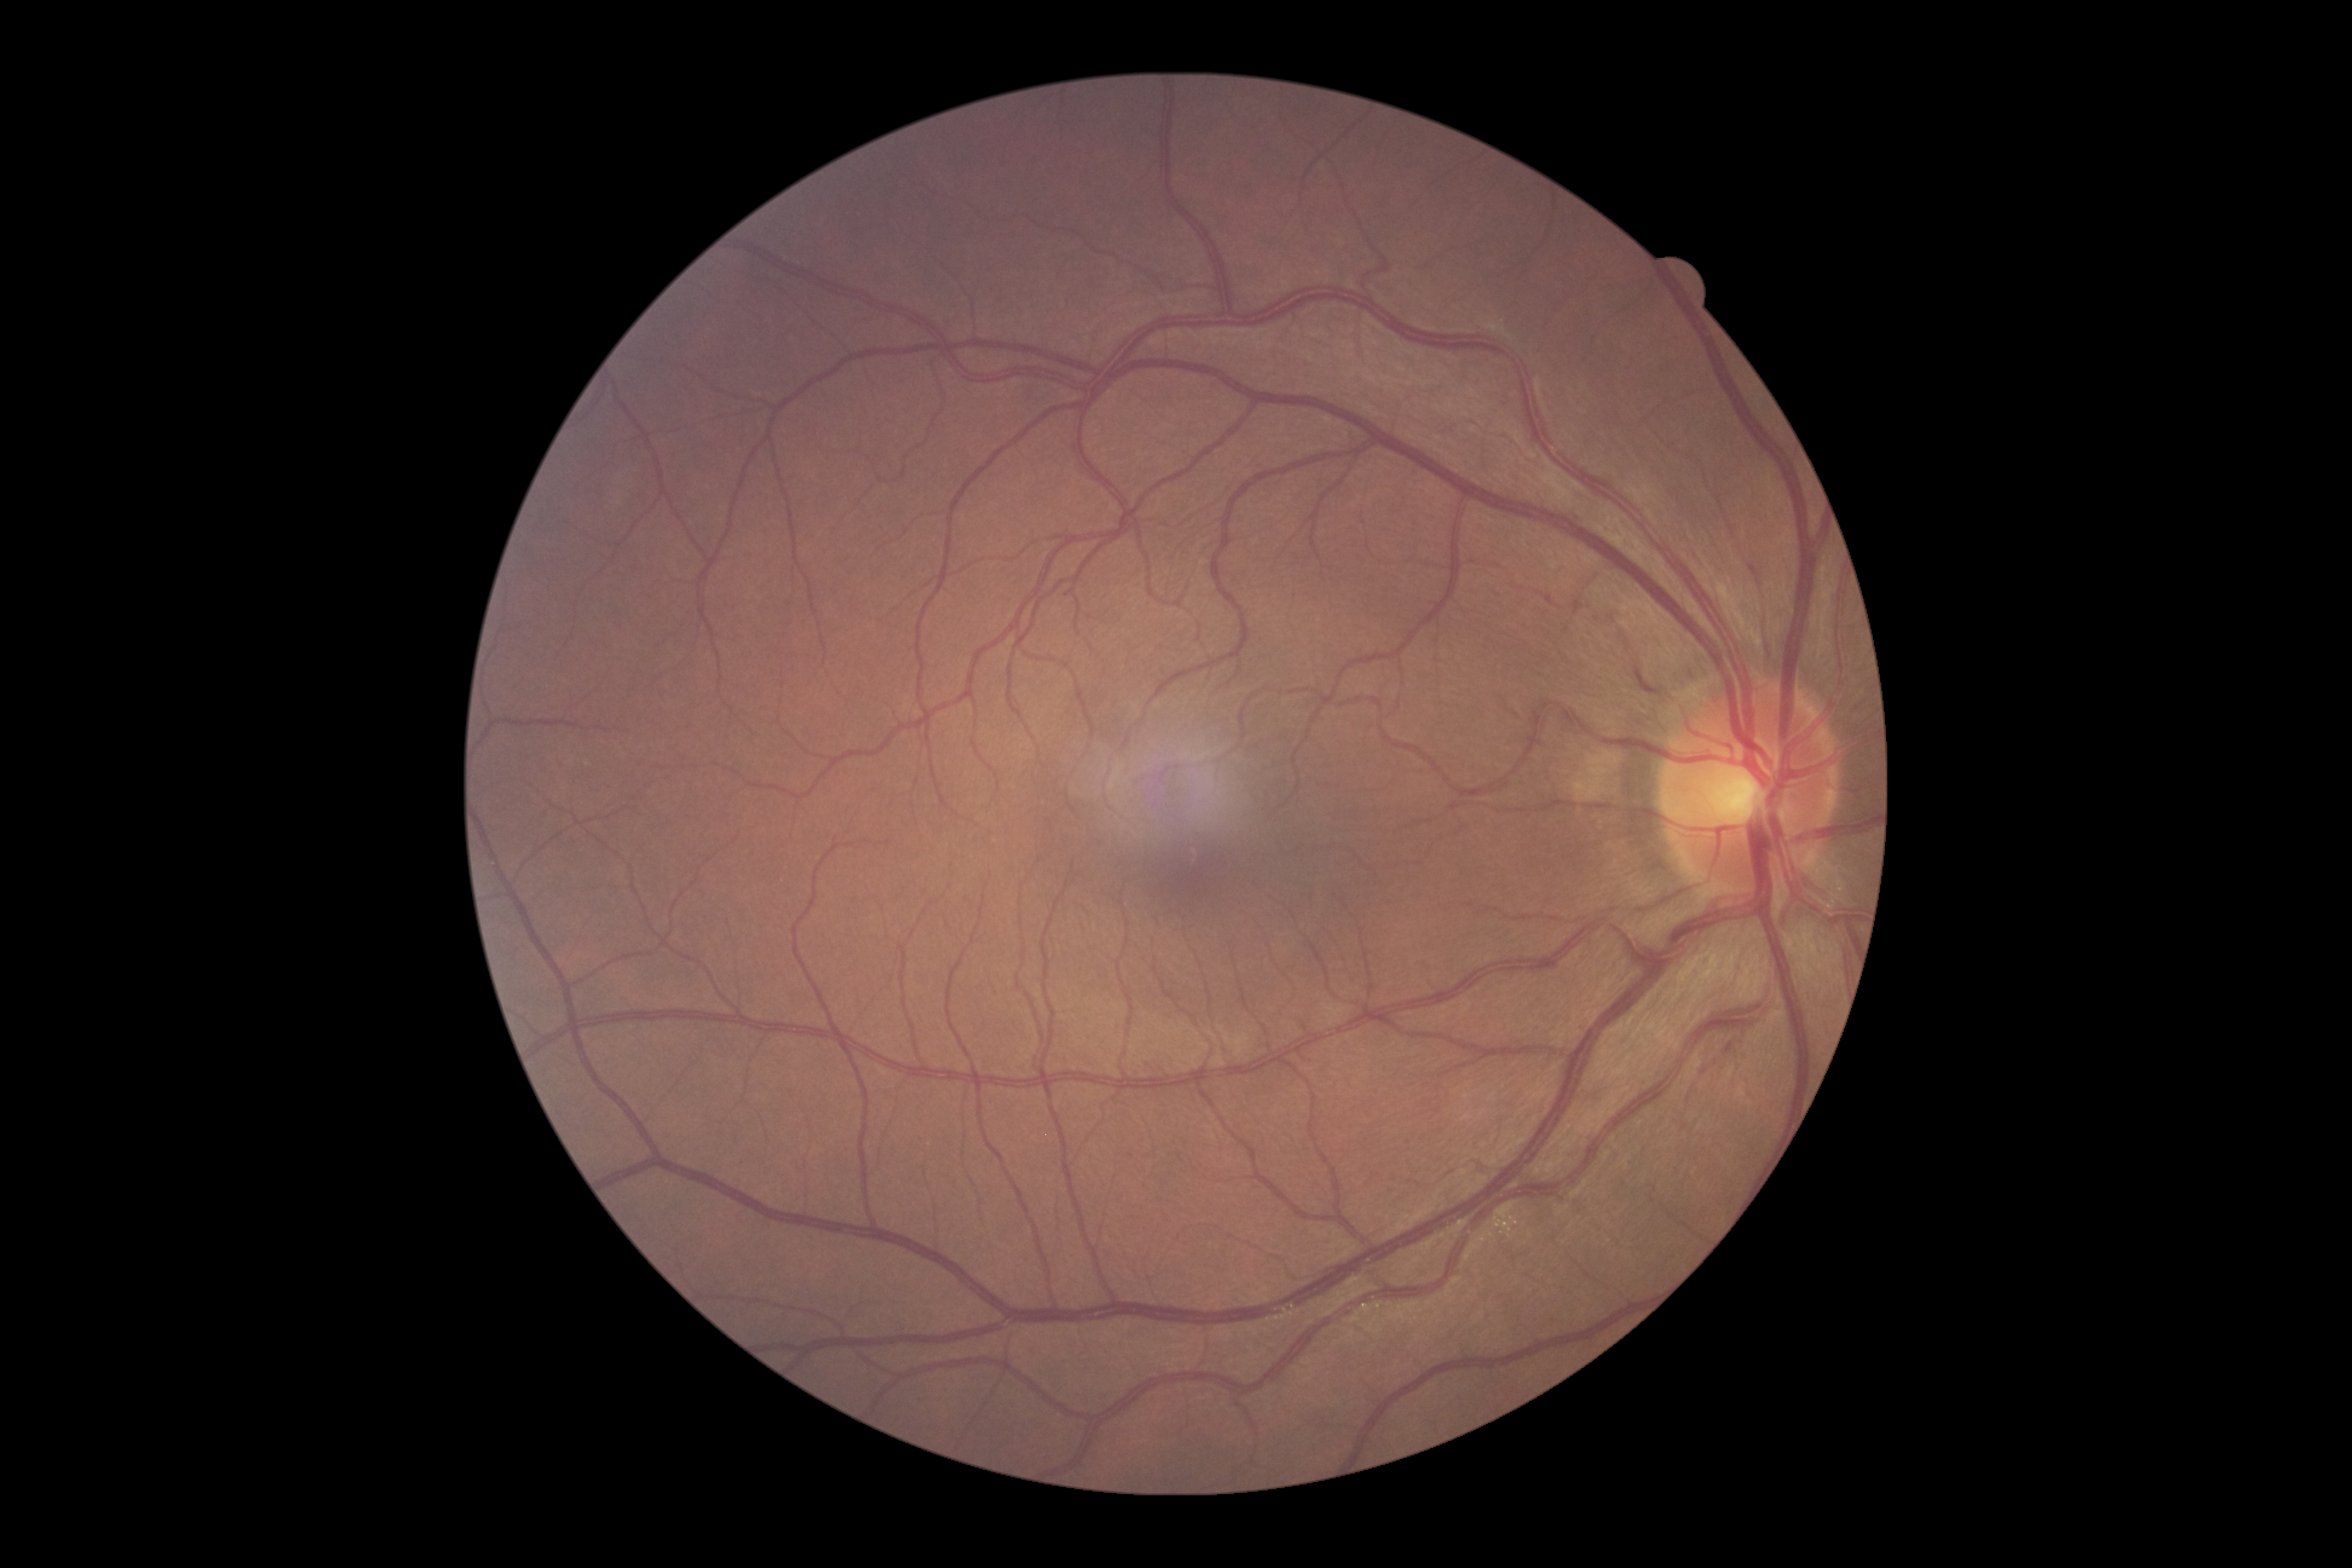 Diabetic retinopathy grade is no apparent diabetic retinopathy (0).